Retinal fundus photograph; captured on a Topcon TRC-NW400 fundus camera; 30-degree field of view; 2212x1661; non-mydriatic acquisition; optic disc at the center of the field.
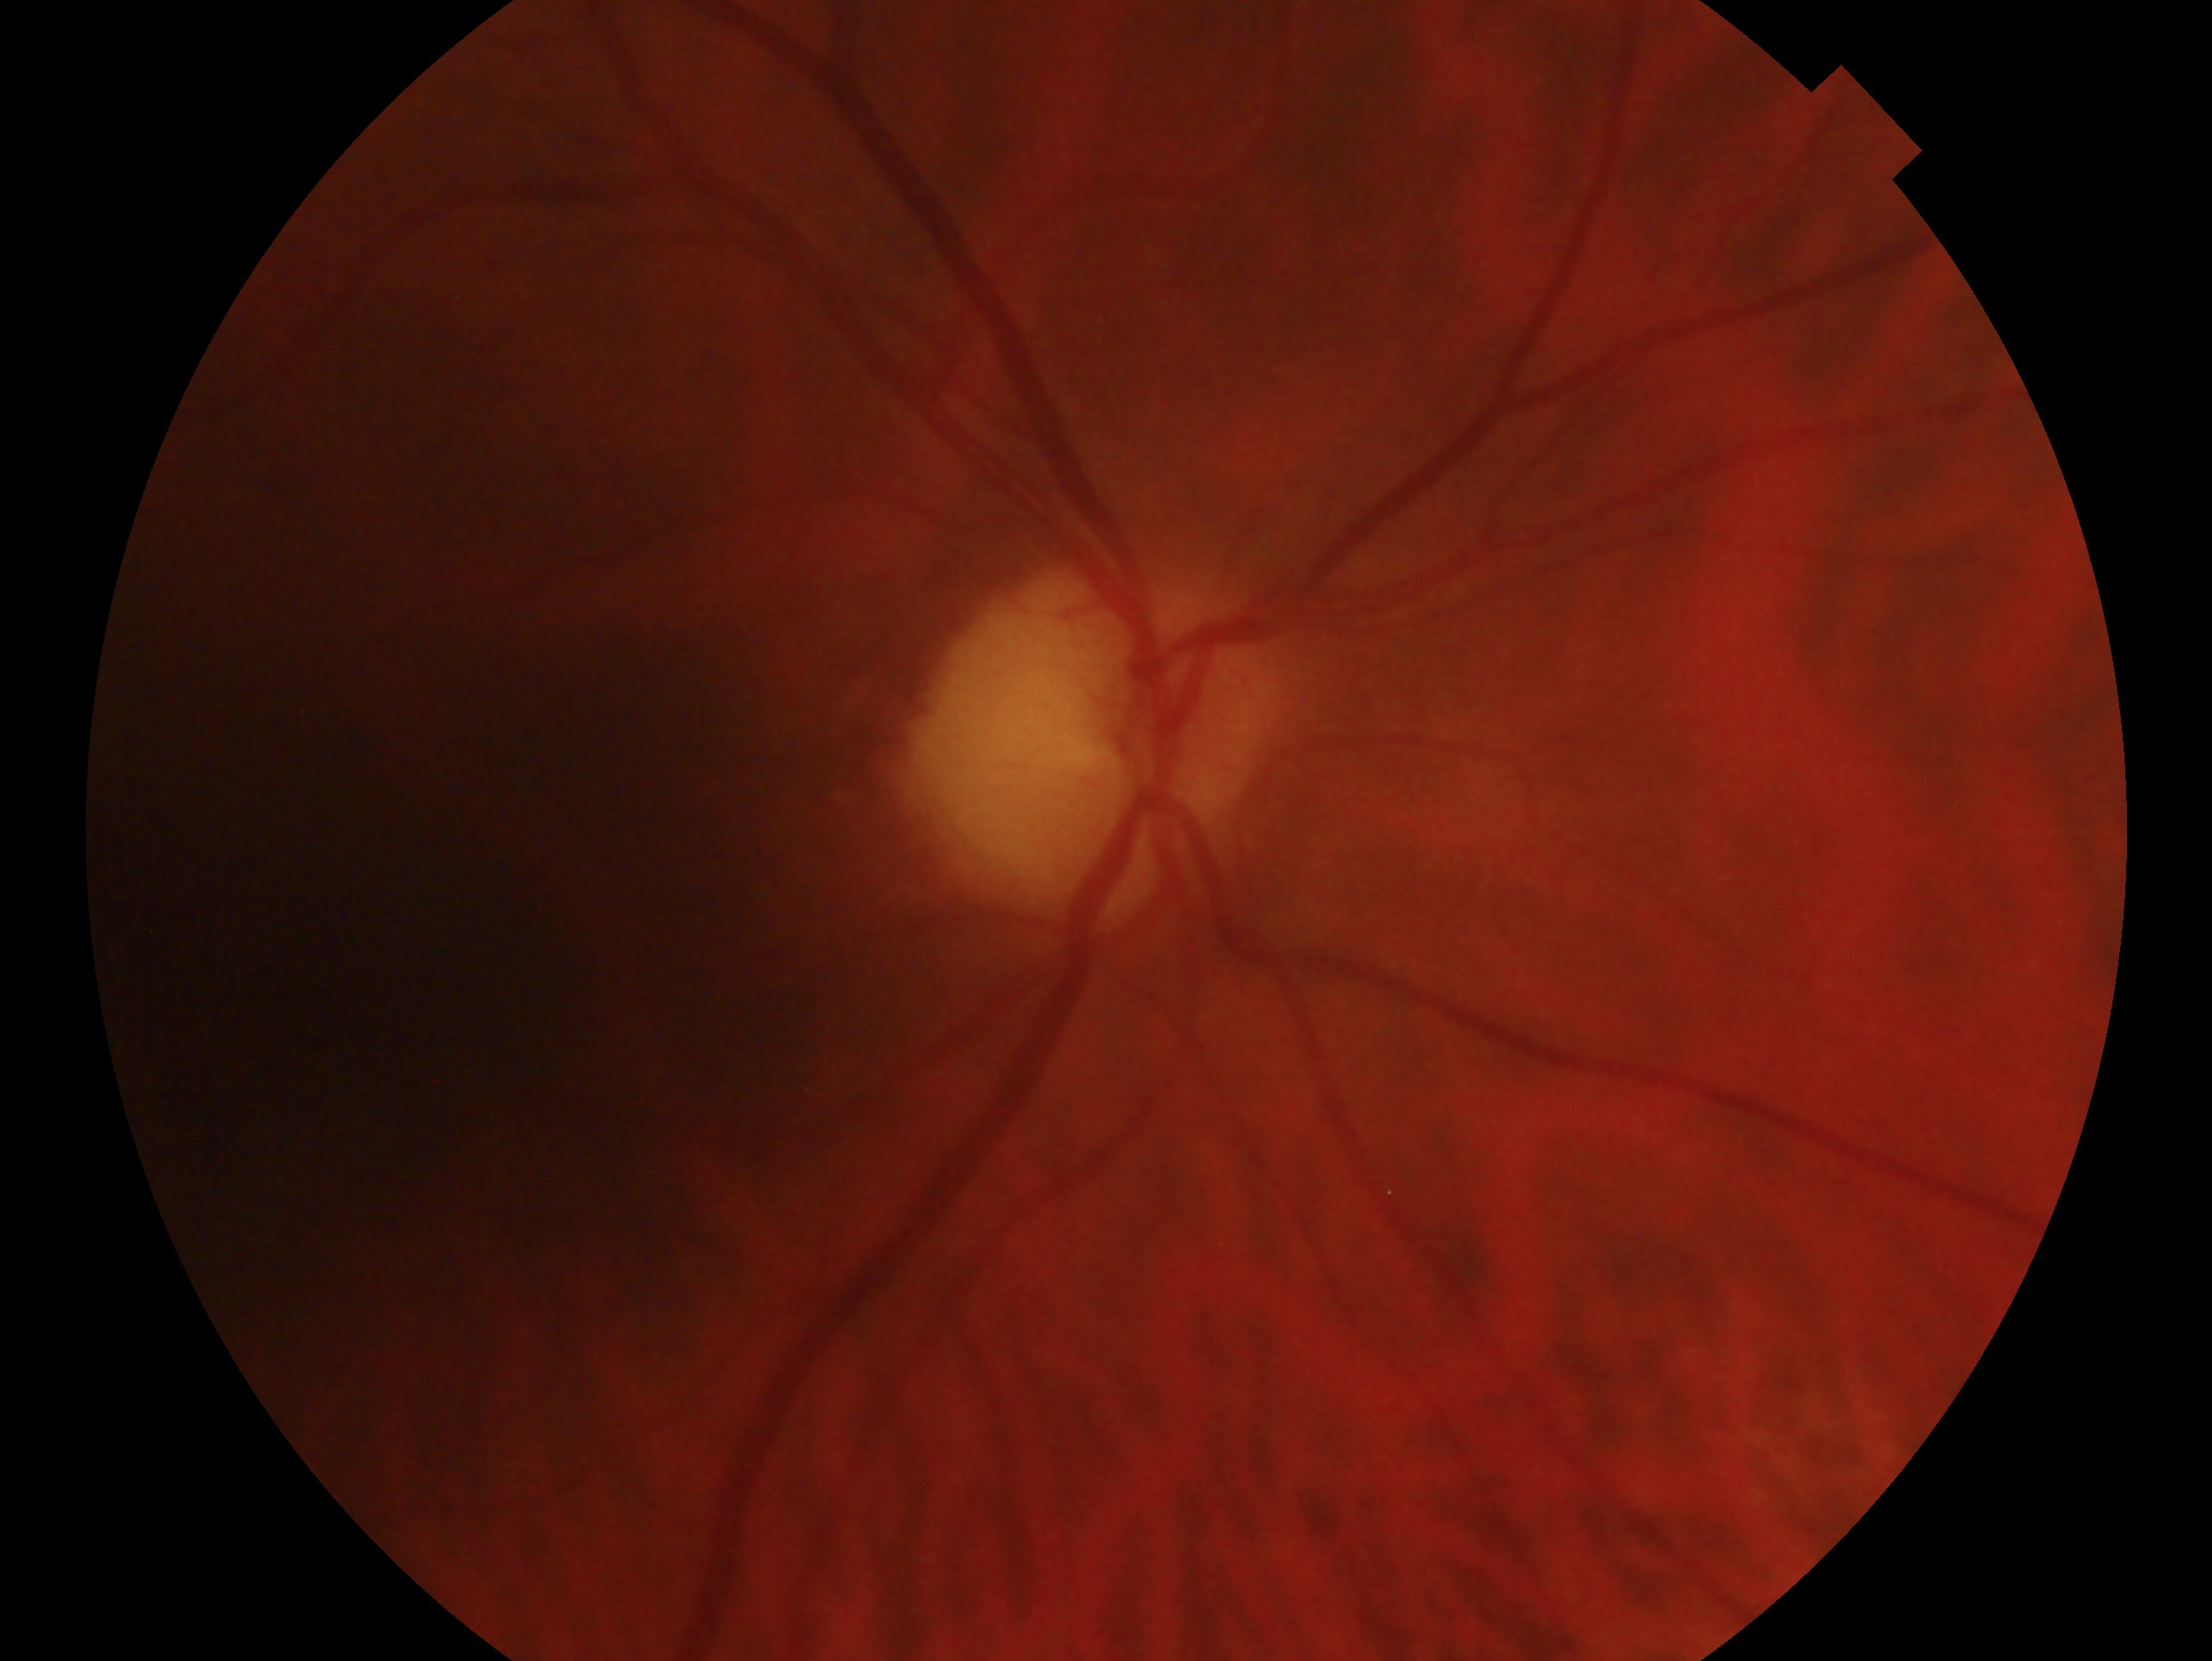 {"glaucoma_dx": "no glaucomatous findings", "eye": "oculus dexter"}